Pediatric wide-field fundus photograph: 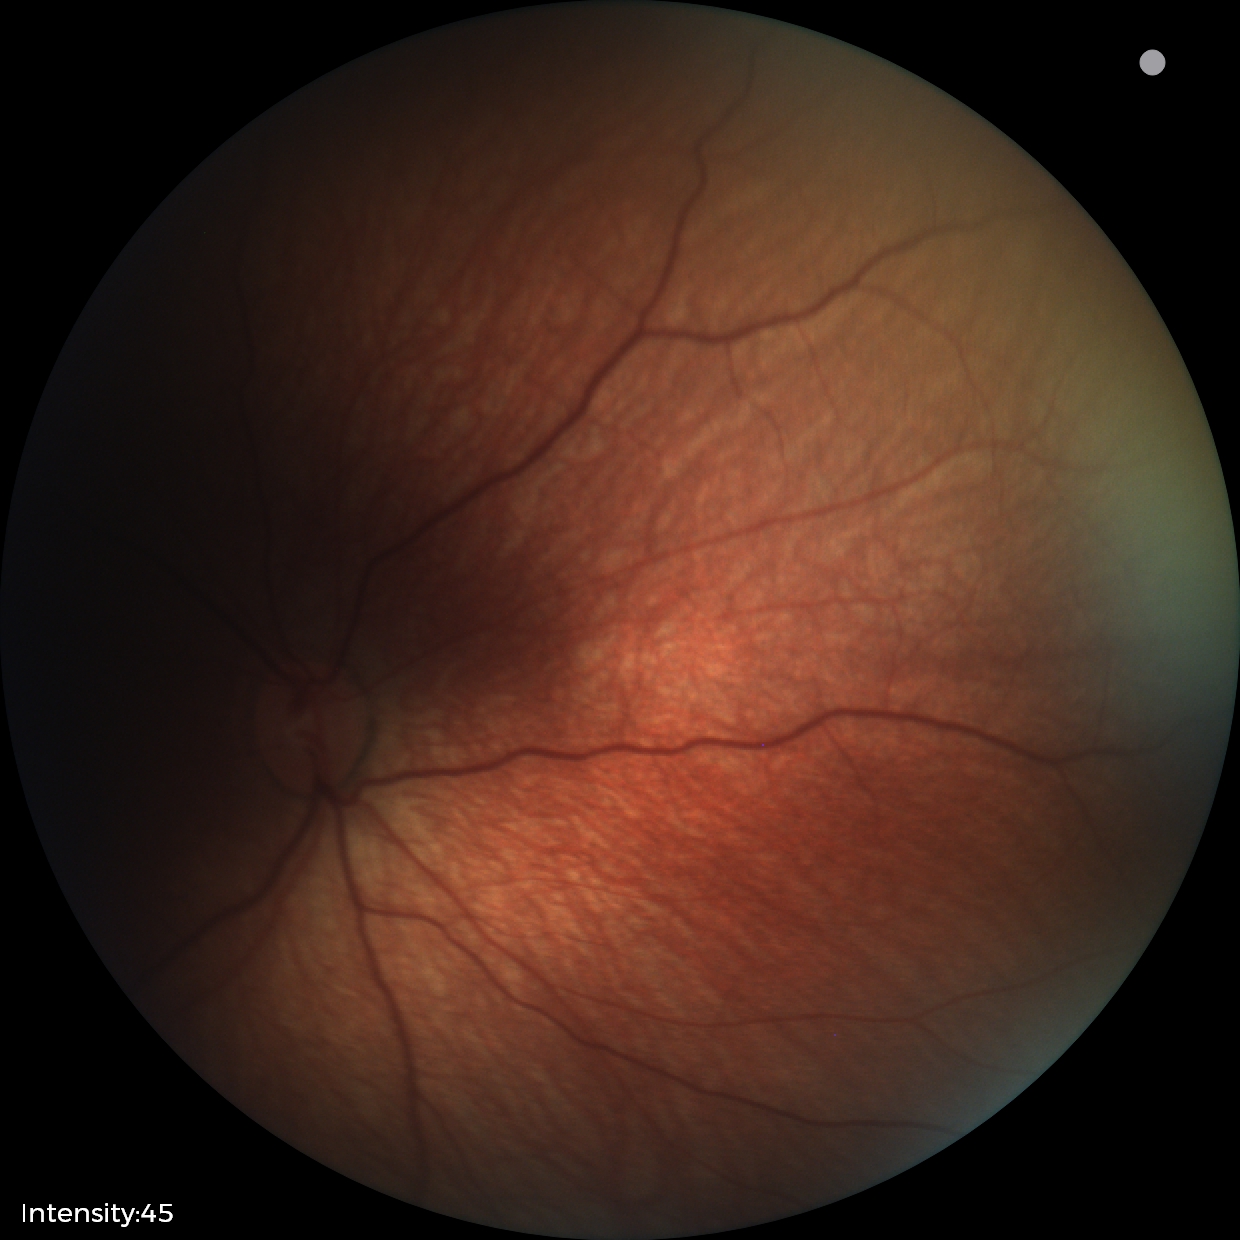
No retinal pathology identified on screening.